2352x1568px; CFP — 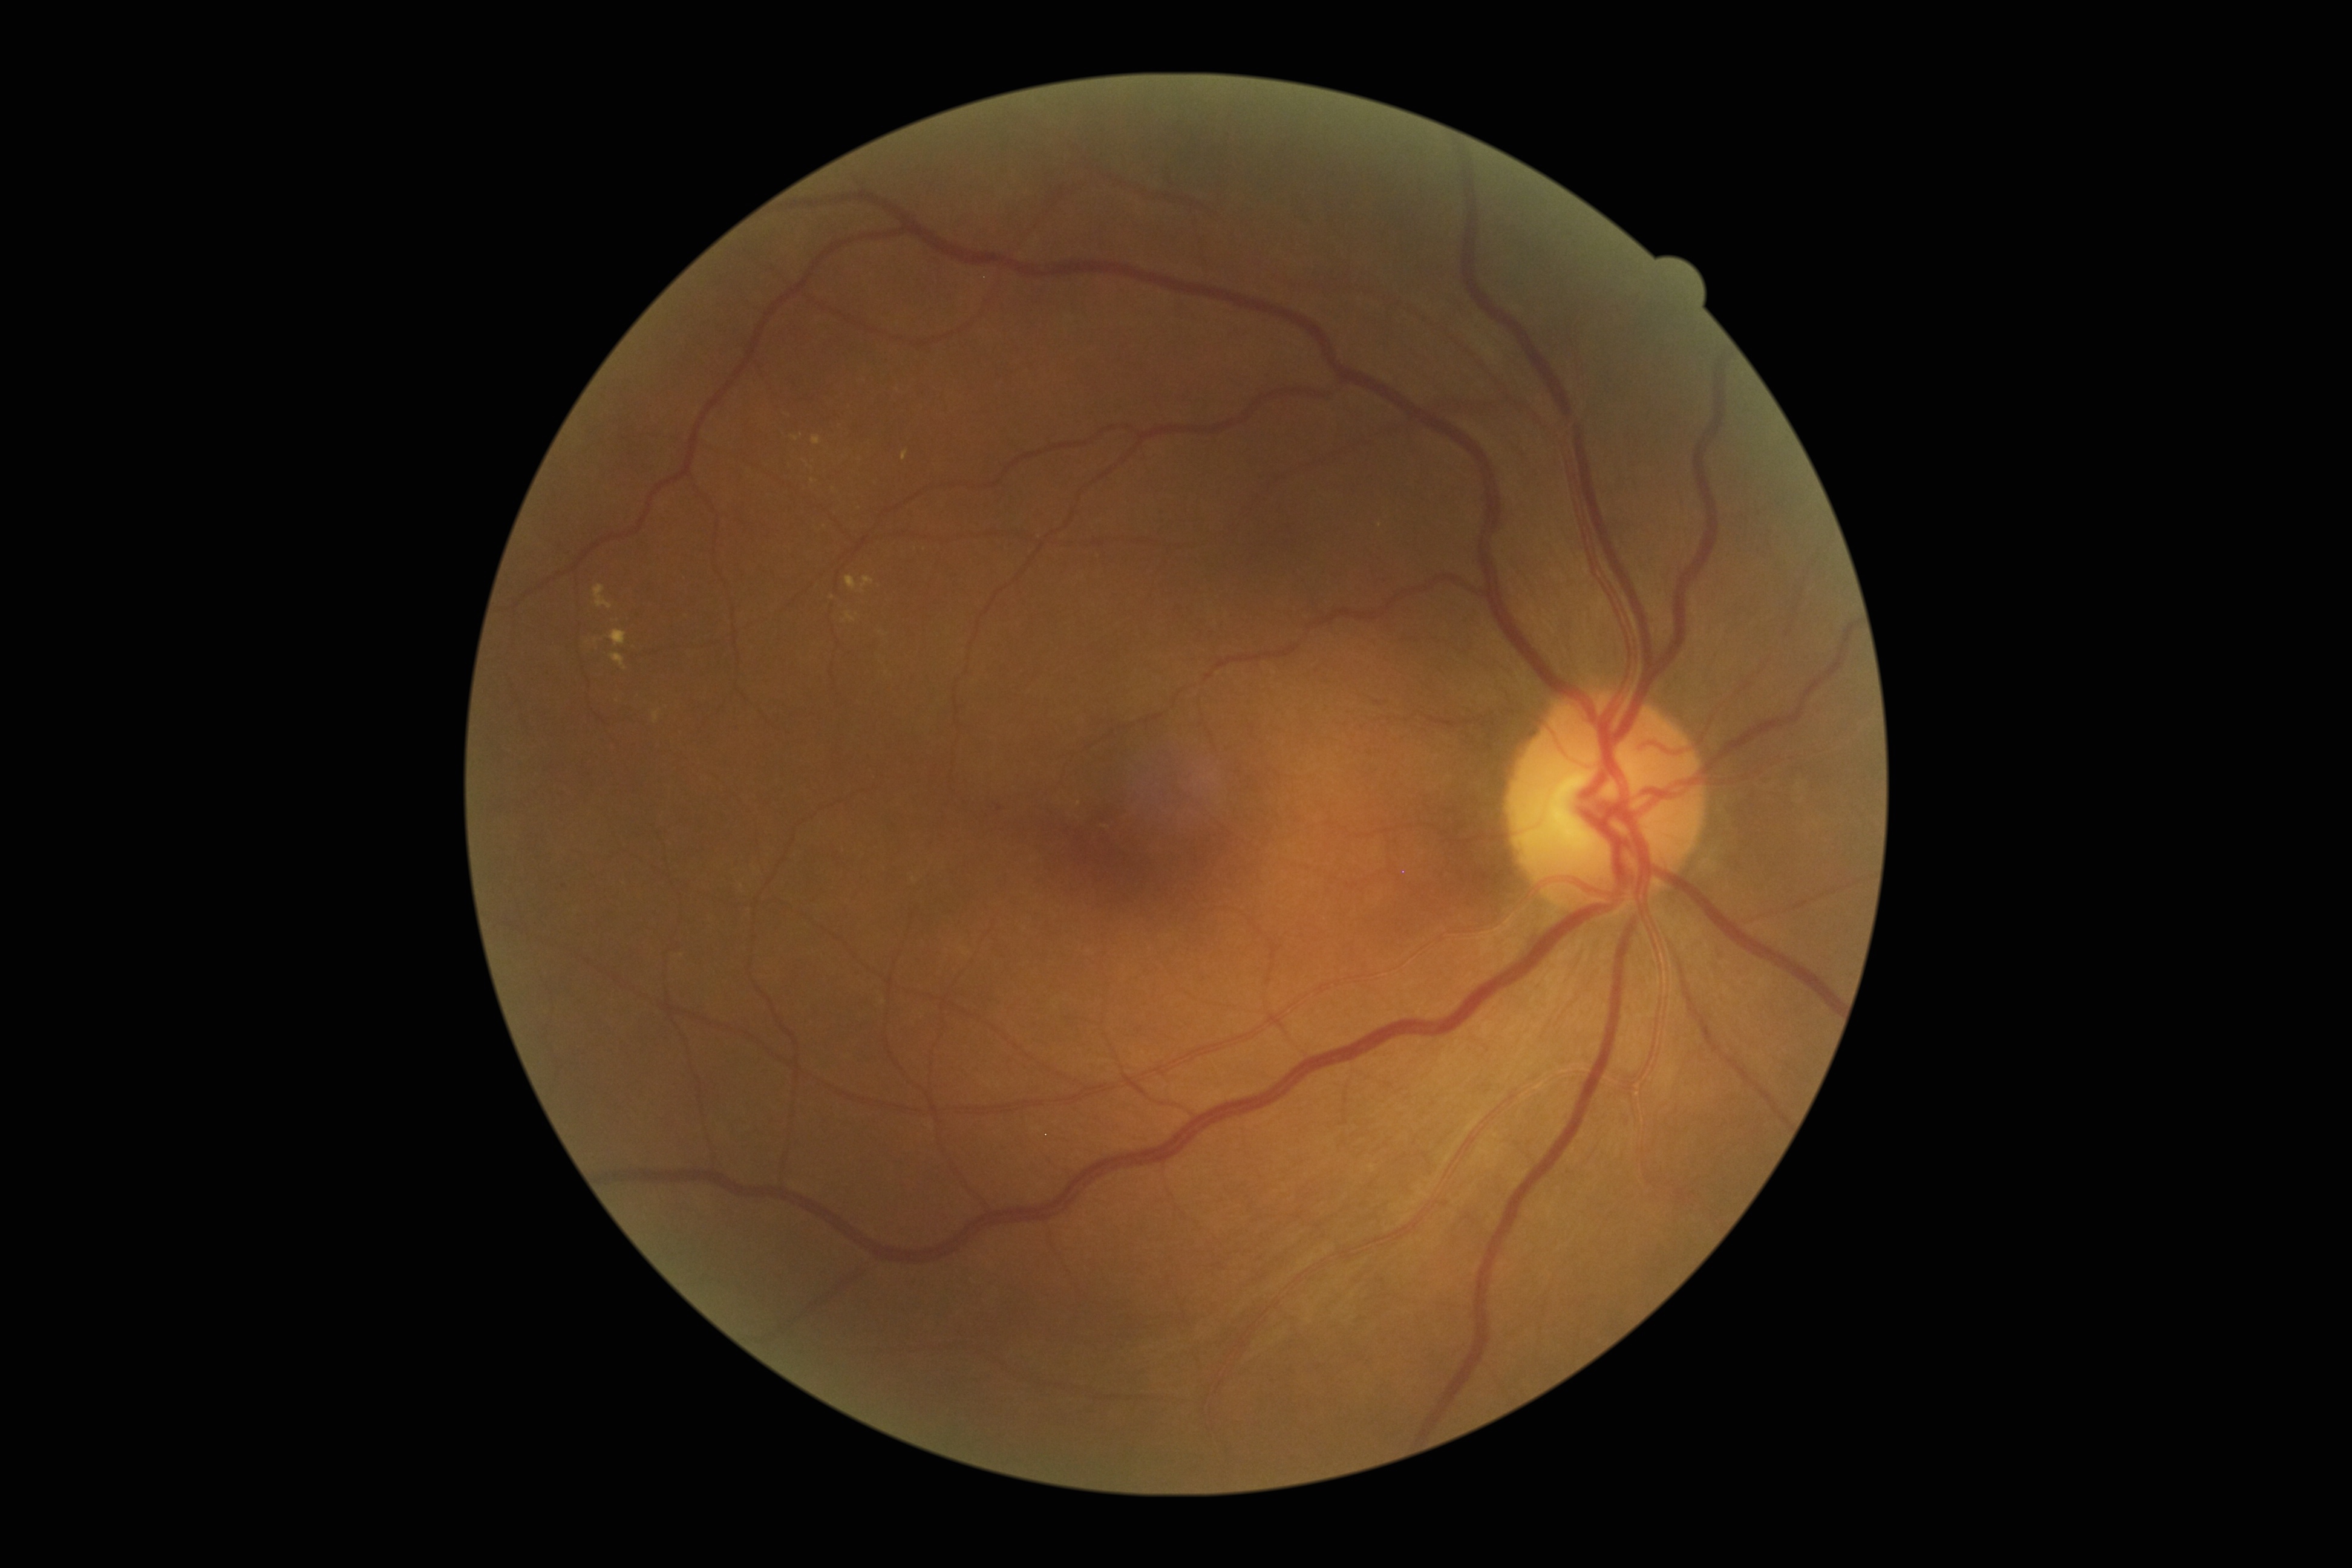
Retinopathy grade: 2 (moderate NPDR).